Phoenix ICON wide-field infant fundus image · captured with the Phoenix ICON (100° field of view):
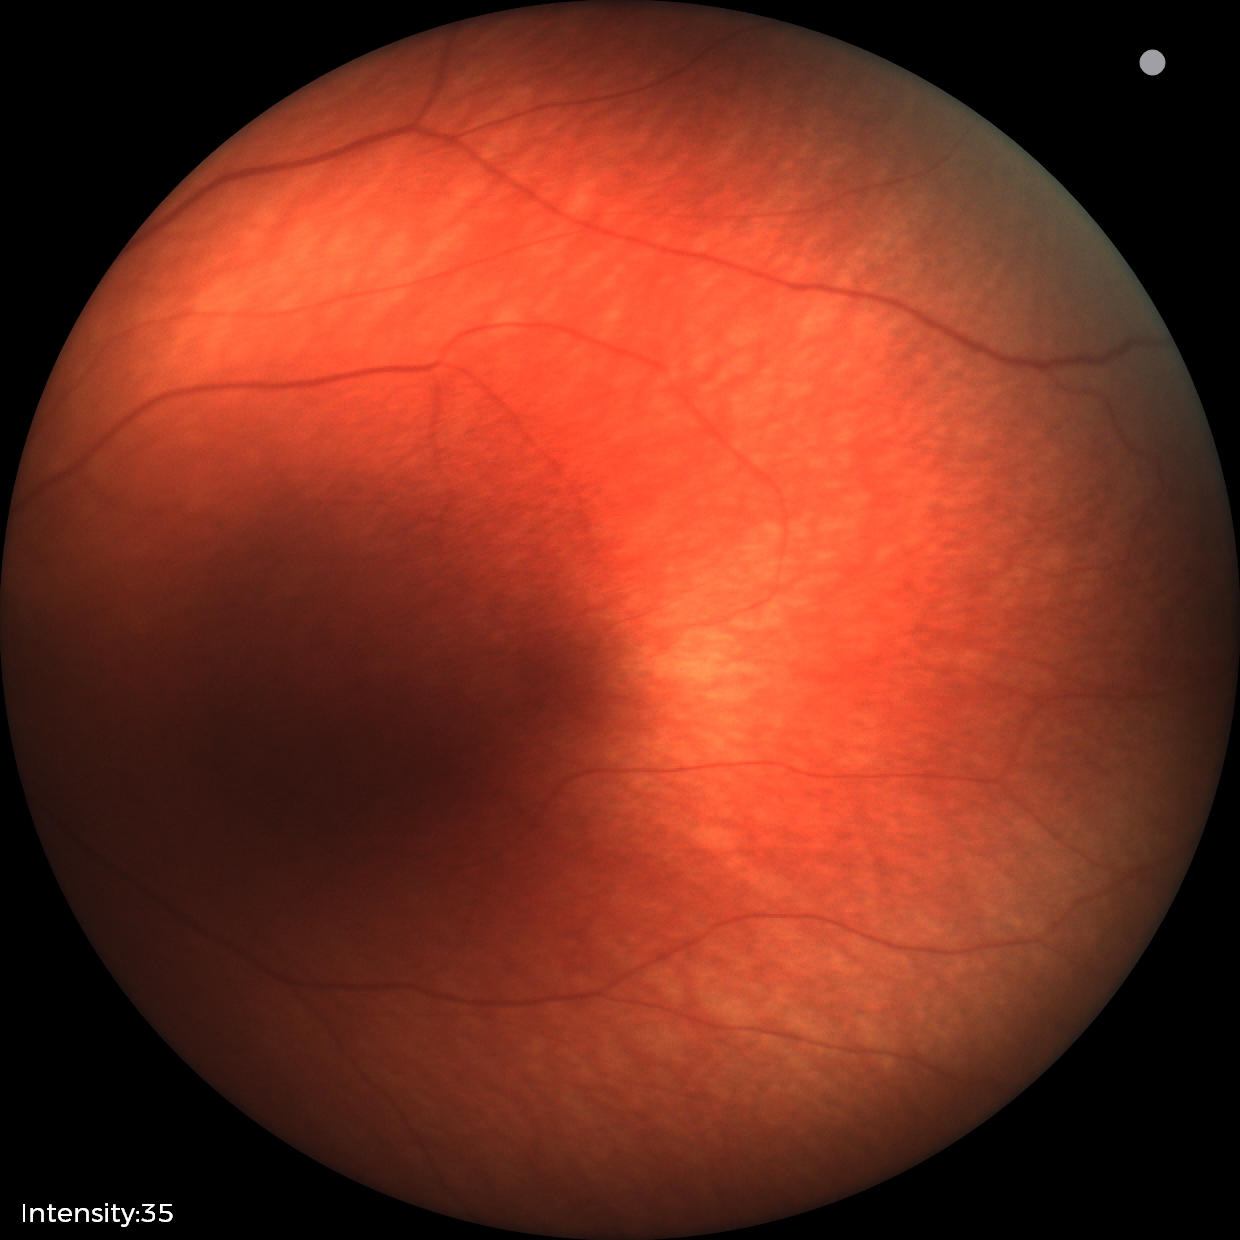

Examination with physiological retinal findings.